Pediatric retinal photograph (wide-field) · 1240 by 1240 pixels
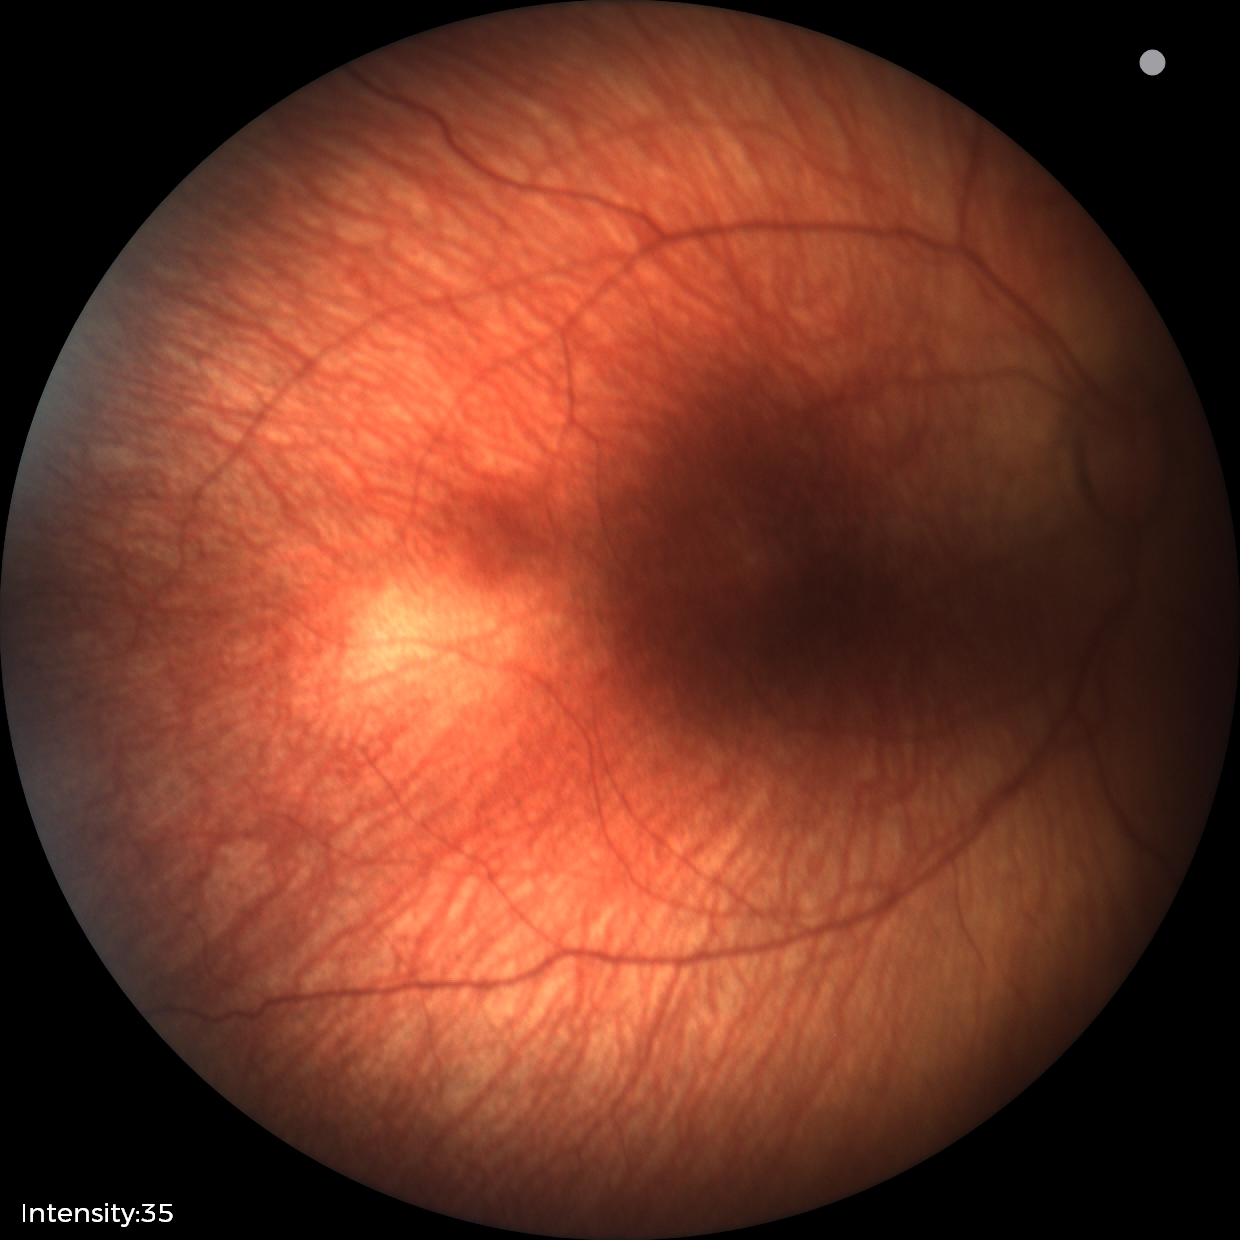

Plus disease absent. Series diagnosed as status post ROP.